Retinal fundus photograph. 45° field of view — 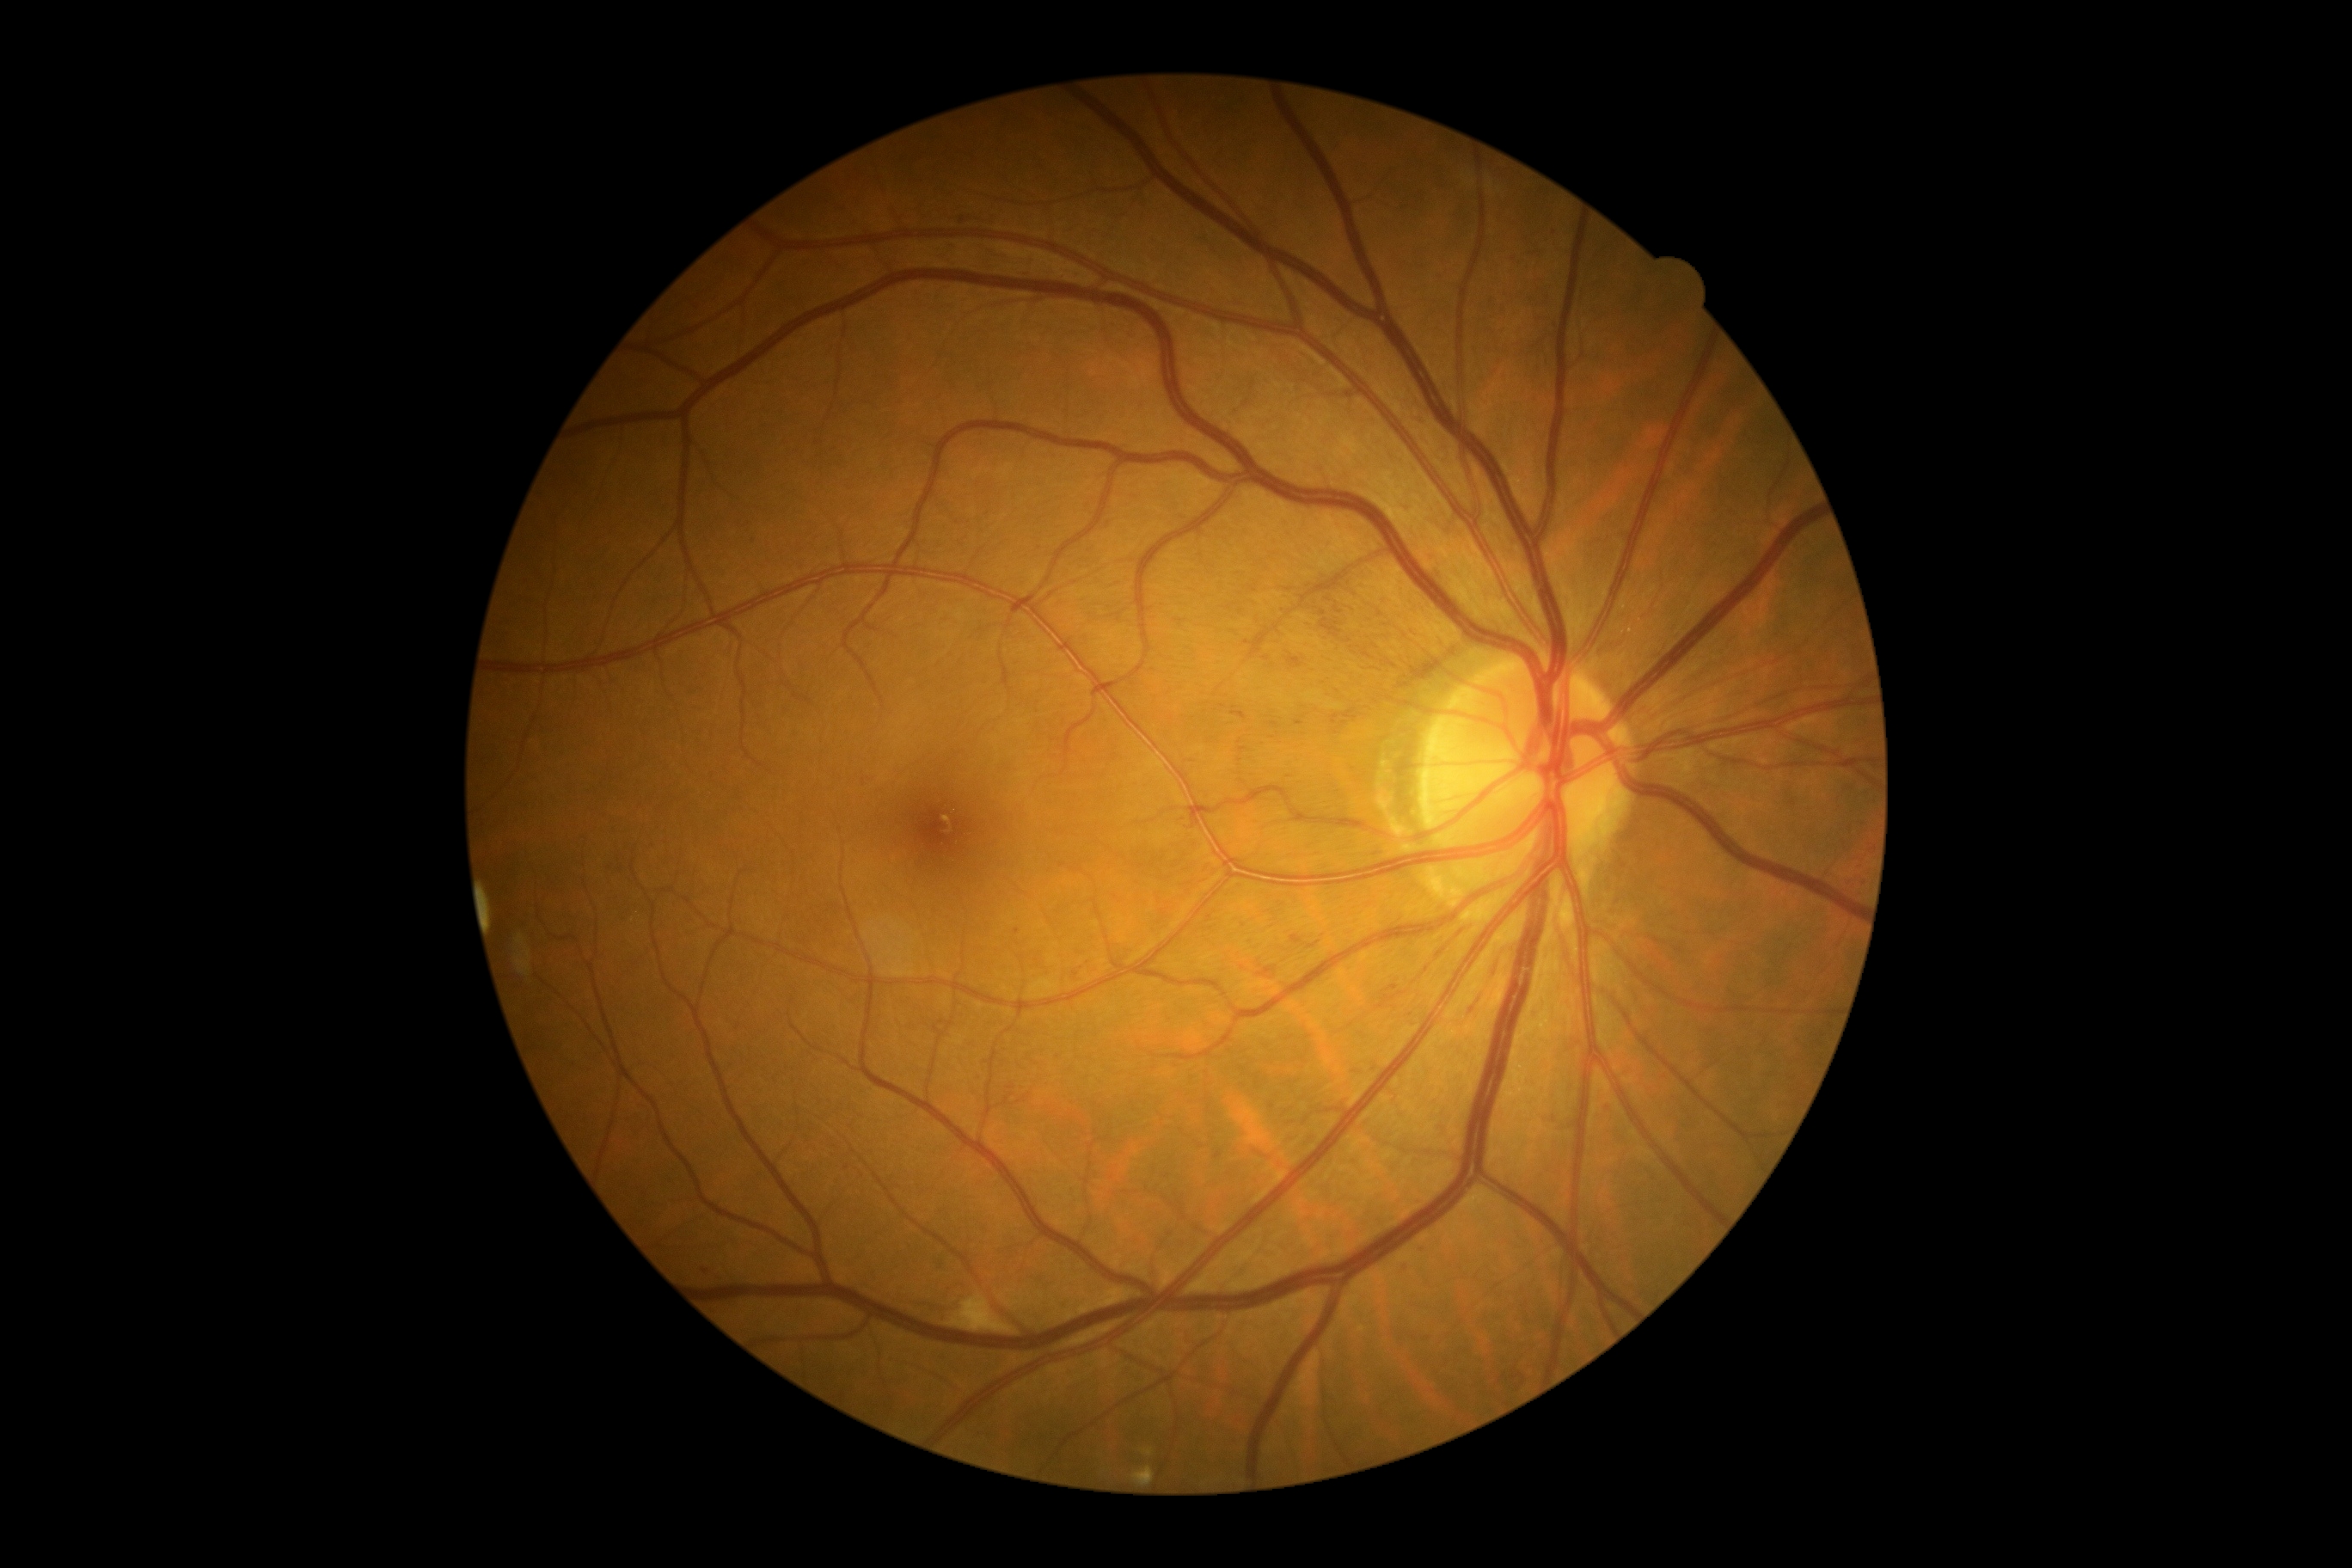

{"dr_grade":2,"lesions":{"ma":[[1387,986,1399,991],[1345,393,1354,398],[1602,1103,1610,1112],[1421,419,1428,427],[1258,967,1277,977],[1292,934,1302,943],[1295,651,1316,675],[1402,1268,1411,1275]],"ma_small":[[1552,1120],[1017,931],[963,221],[1351,1024],[619,871],[1302,724],[1209,918],[608,869],[1423,1250]],"ex":[[1132,1467,1155,1483],[1144,1450,1153,1457]],"se":[[946,1292,1014,1335]],"he":null}}